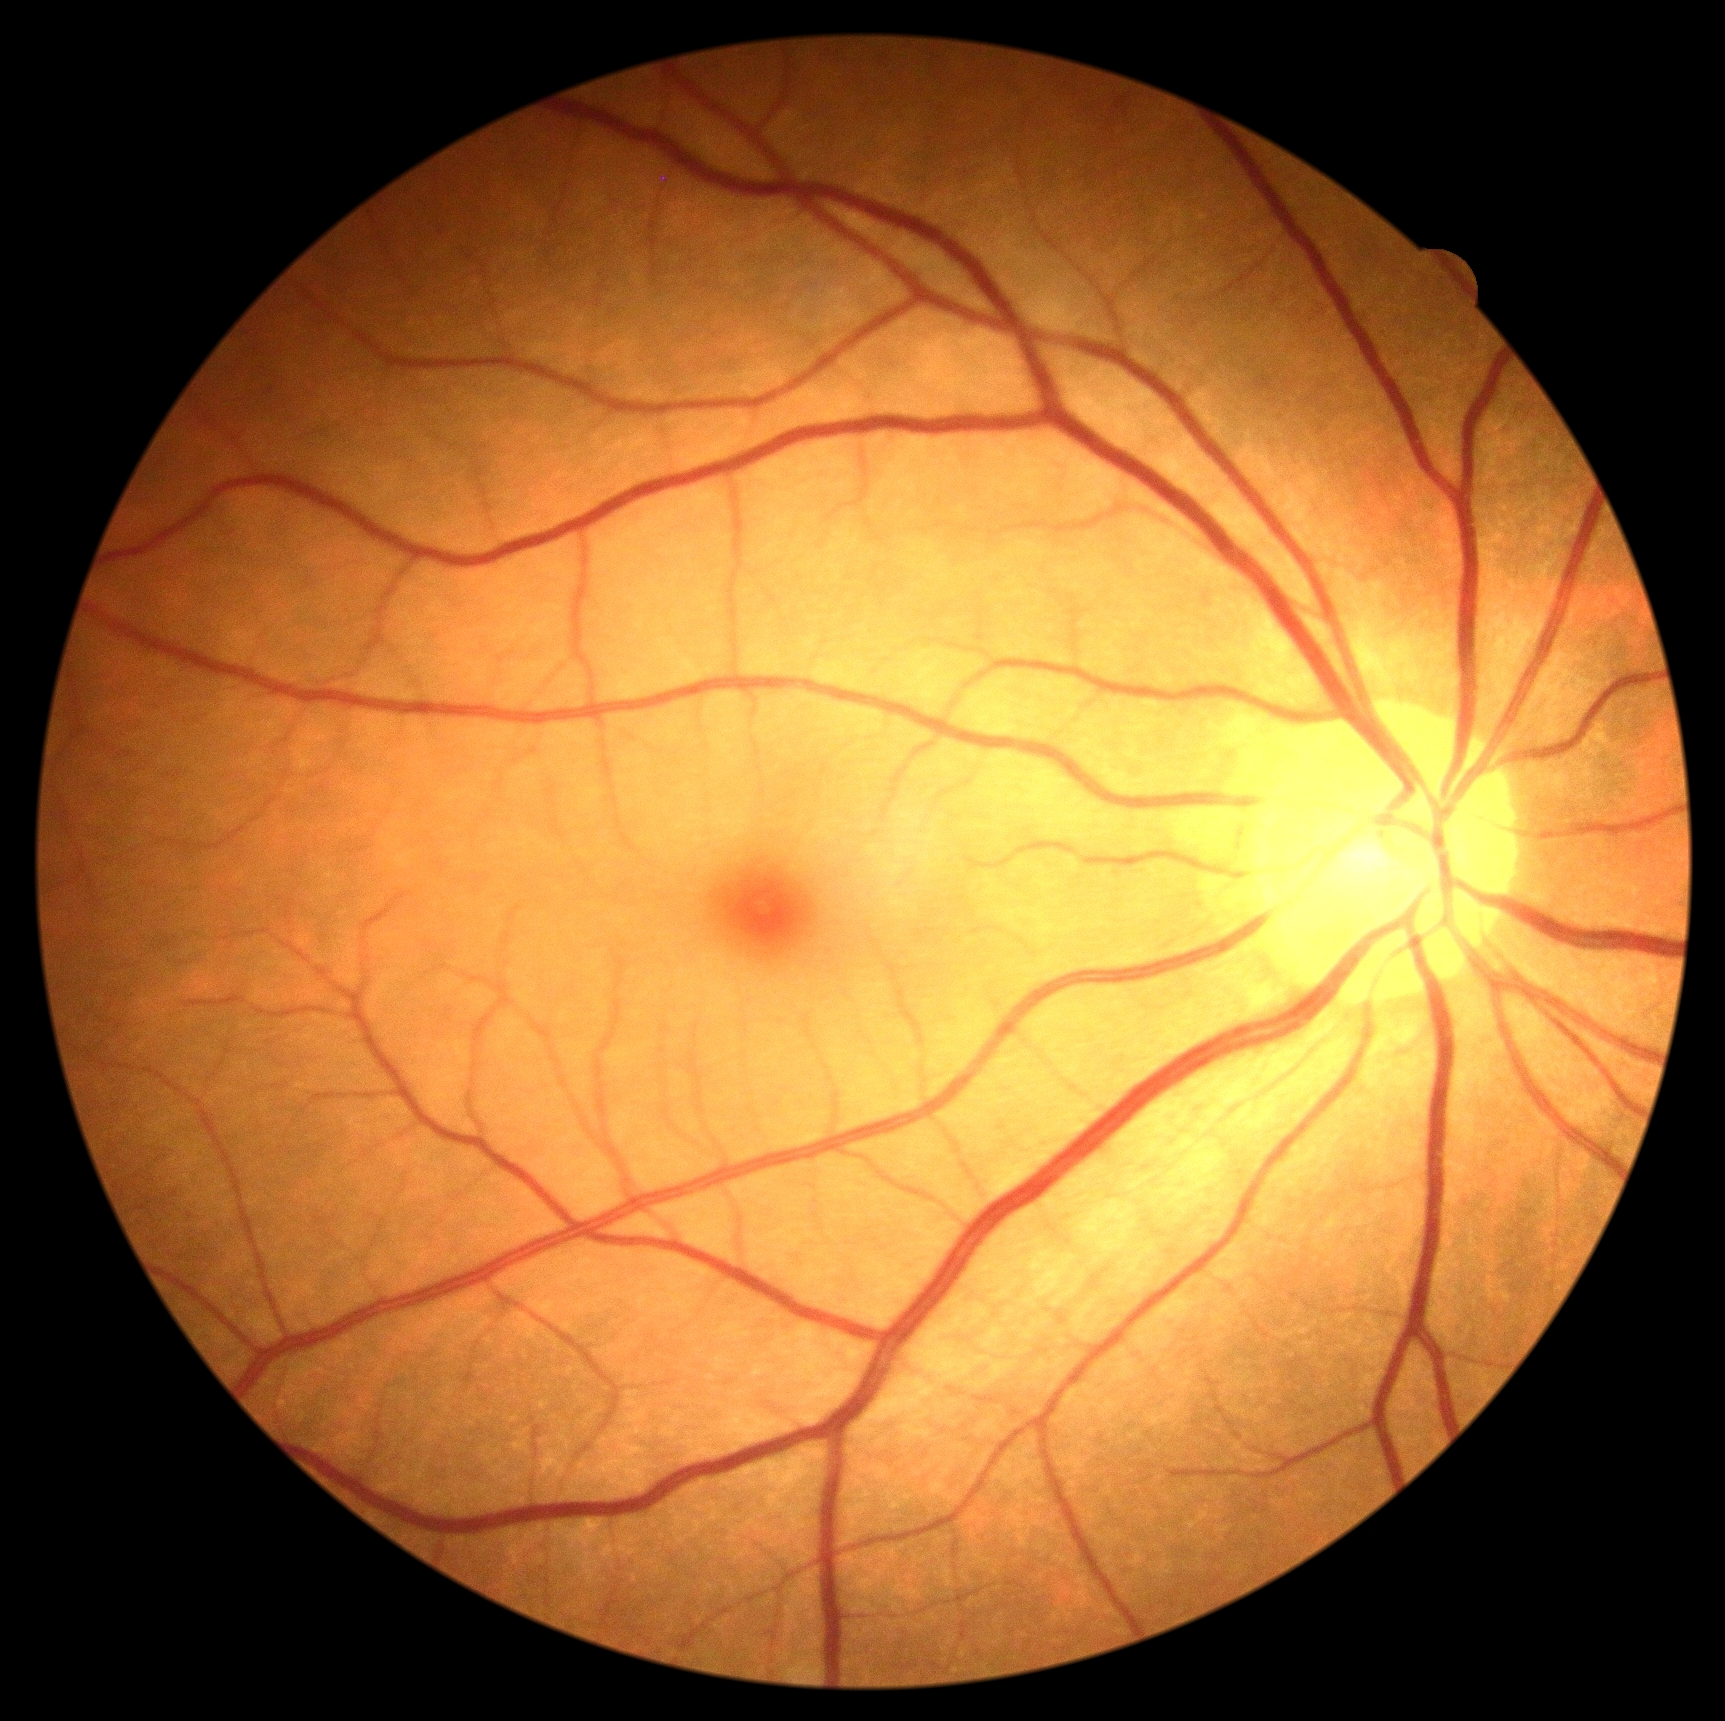 DR grade: no apparent diabetic retinopathy (0) — no visible signs of diabetic retinopathy.